Pupil-dilated, 2361 by 1568 pixels, retinal fundus photograph, captured on a Kowa VX-10α fundus camera, macula-centered field: 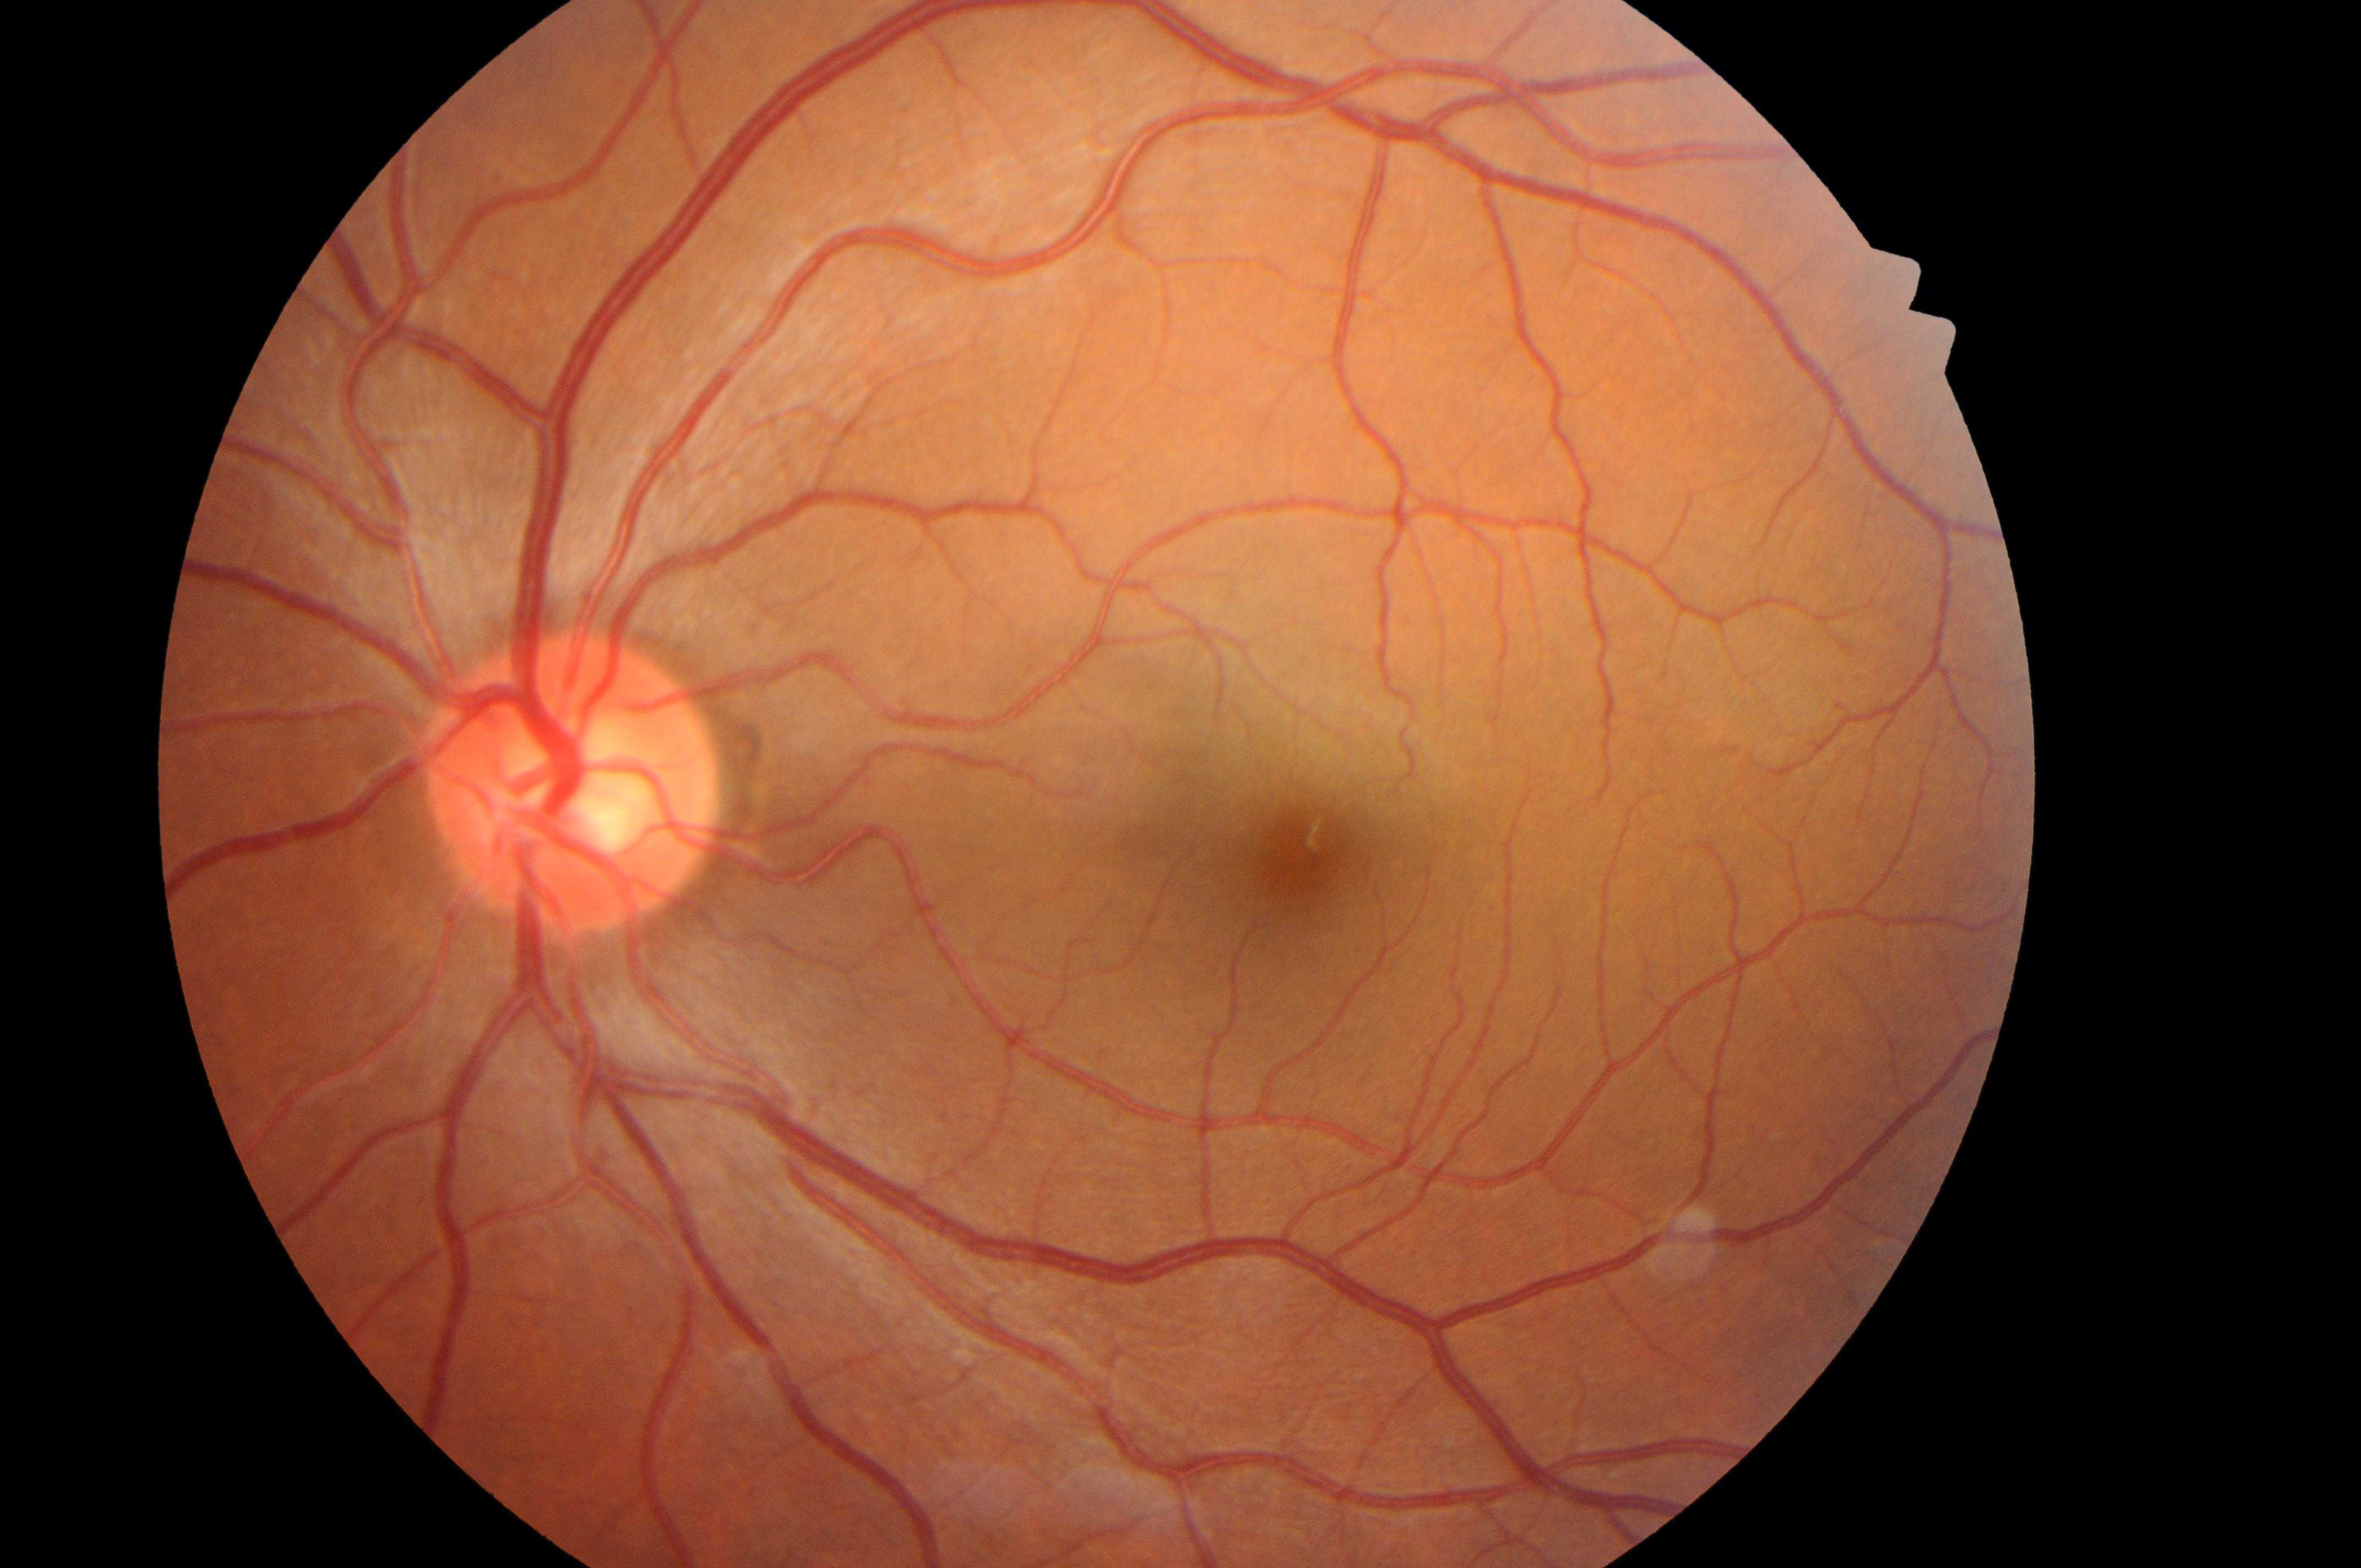 The optic disk is at (563,790). Imaged eye: left eye. Risk of macular edema is grade 0. Diabetic retinopathy is grade 0. The fovea centralis is at (1302,859).